Central posterior field · 2228x1652px · camera: Topcon TRC-50DX · pupil-dilated · fundus photo: 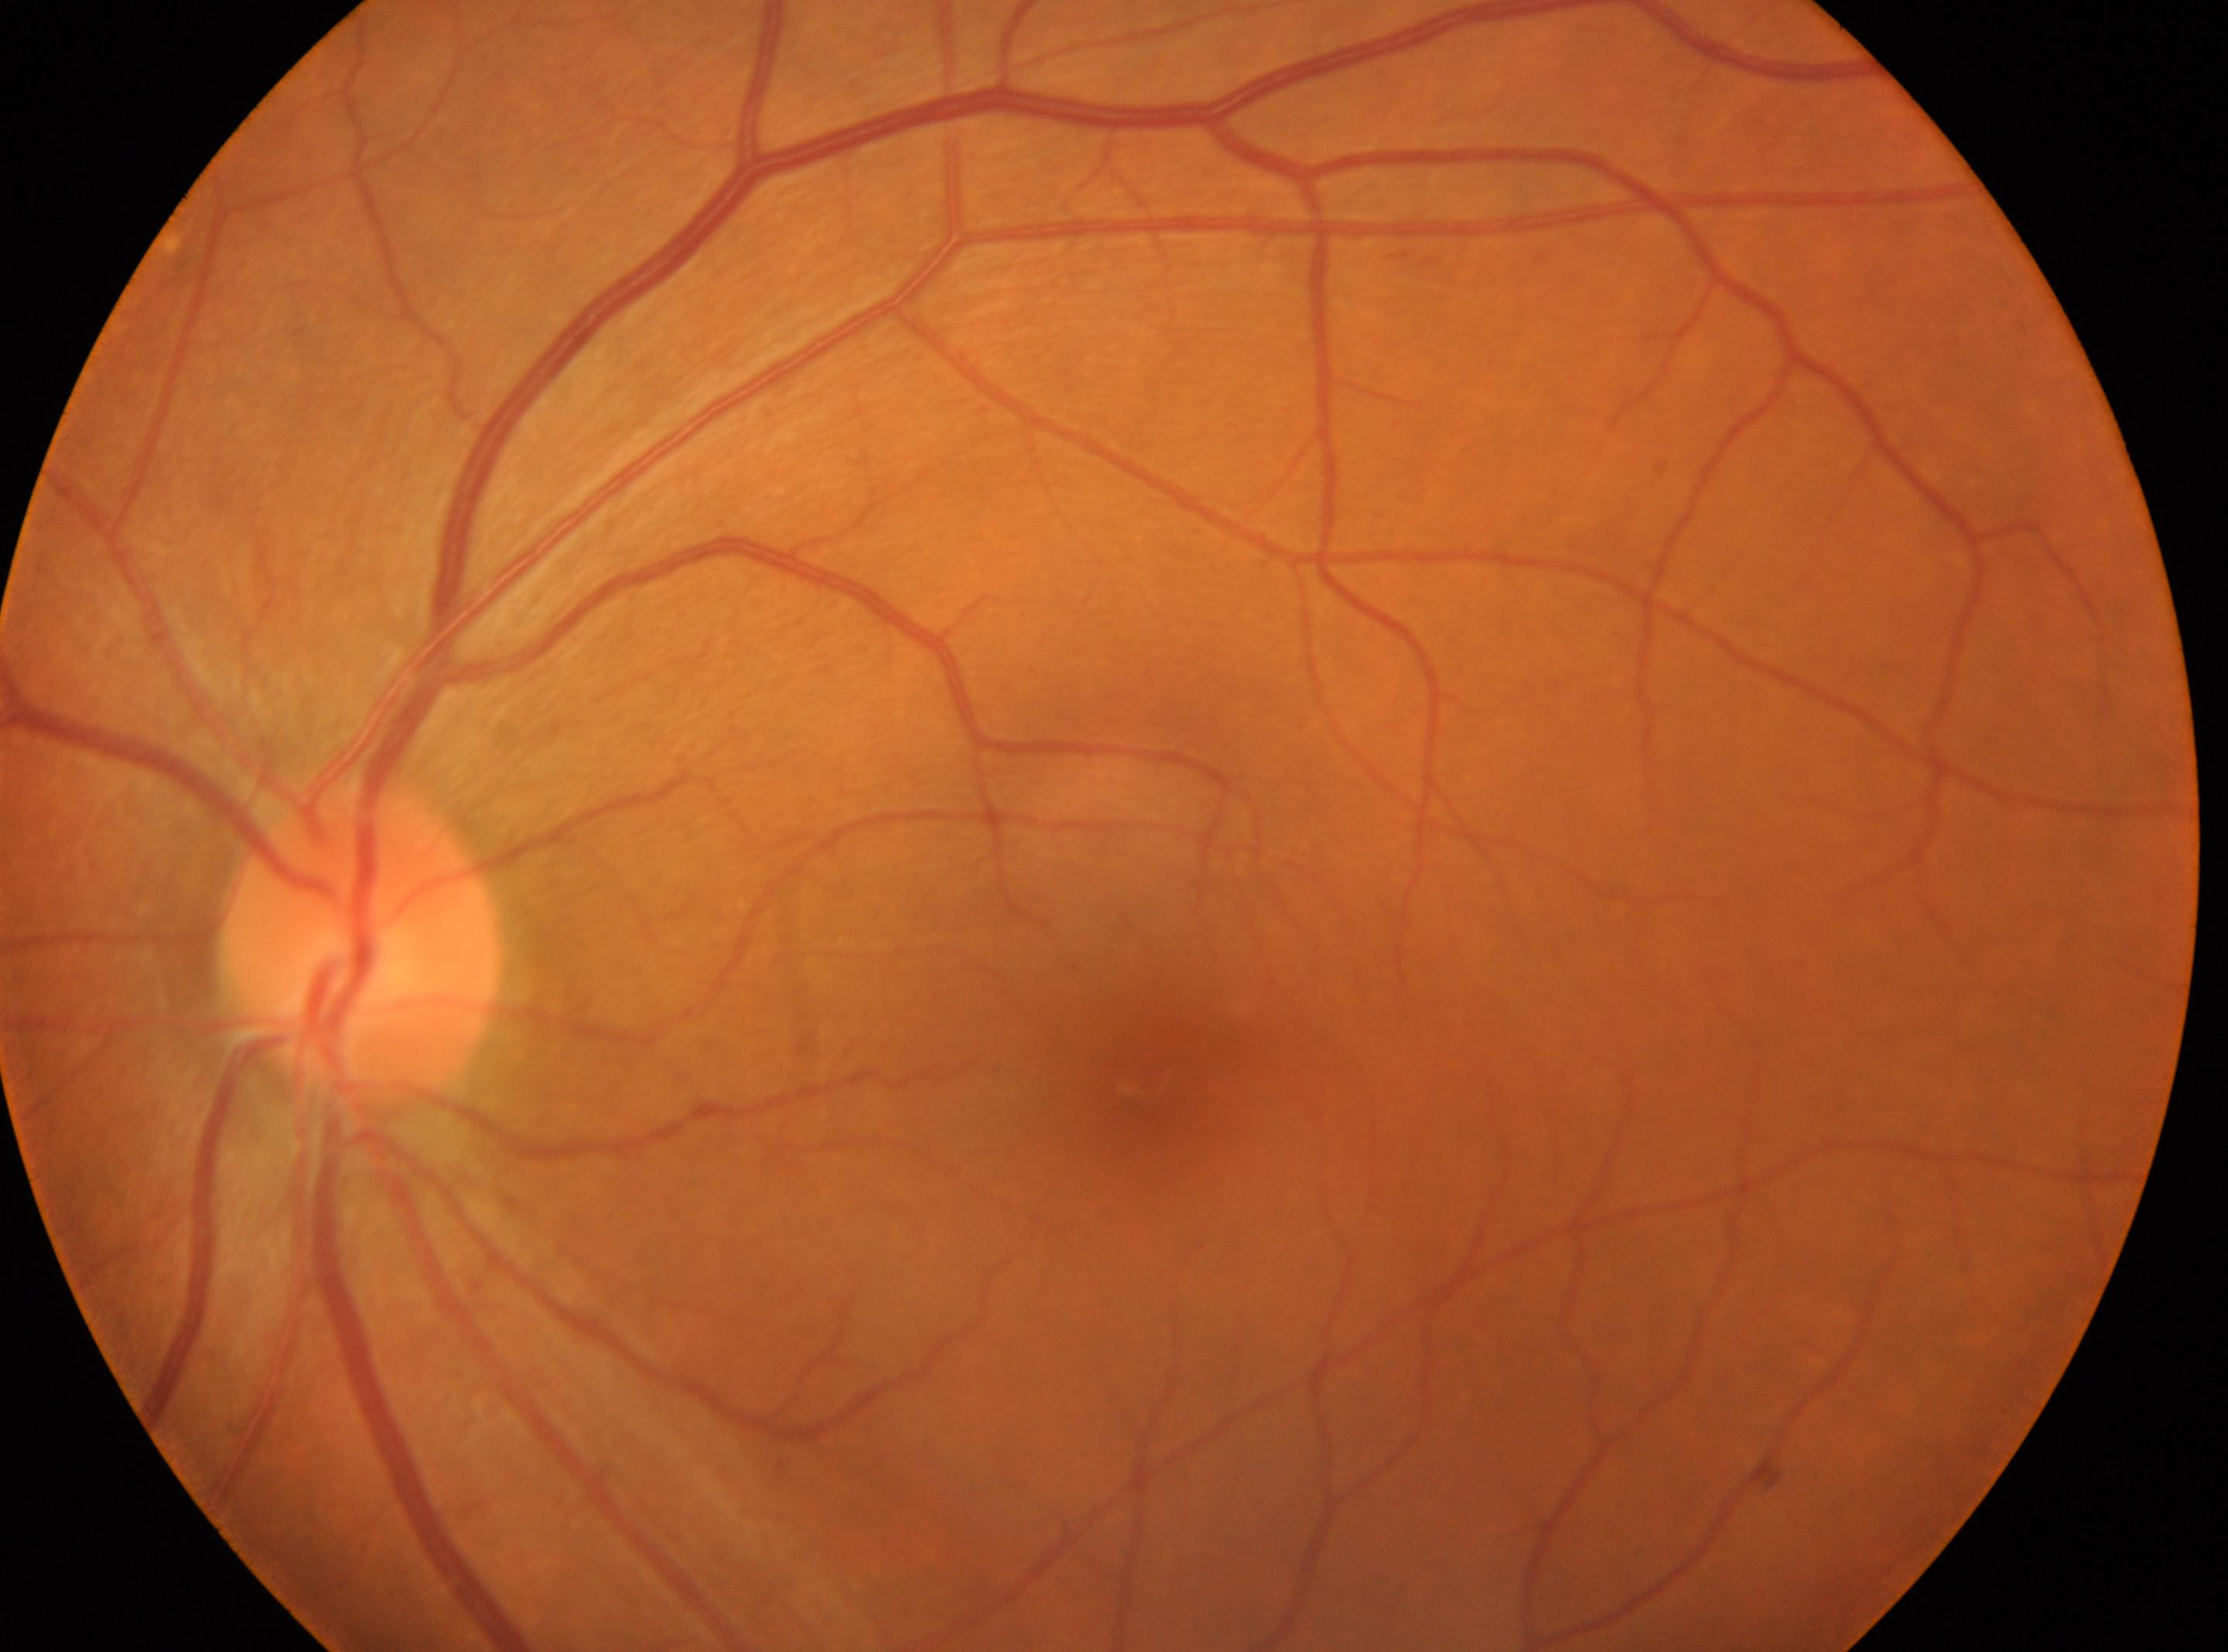

The optic disk is at (357,948).
No diabetic retinopathy identified.
This is the left eye.
Diabetic retinopathy severity is 0/4 — no visible signs of diabetic retinopathy.
Foveal center located at (1145,1078).